Autorefraction: +3 -3.75 x 87. IOP 16 mmHg. Female patient: 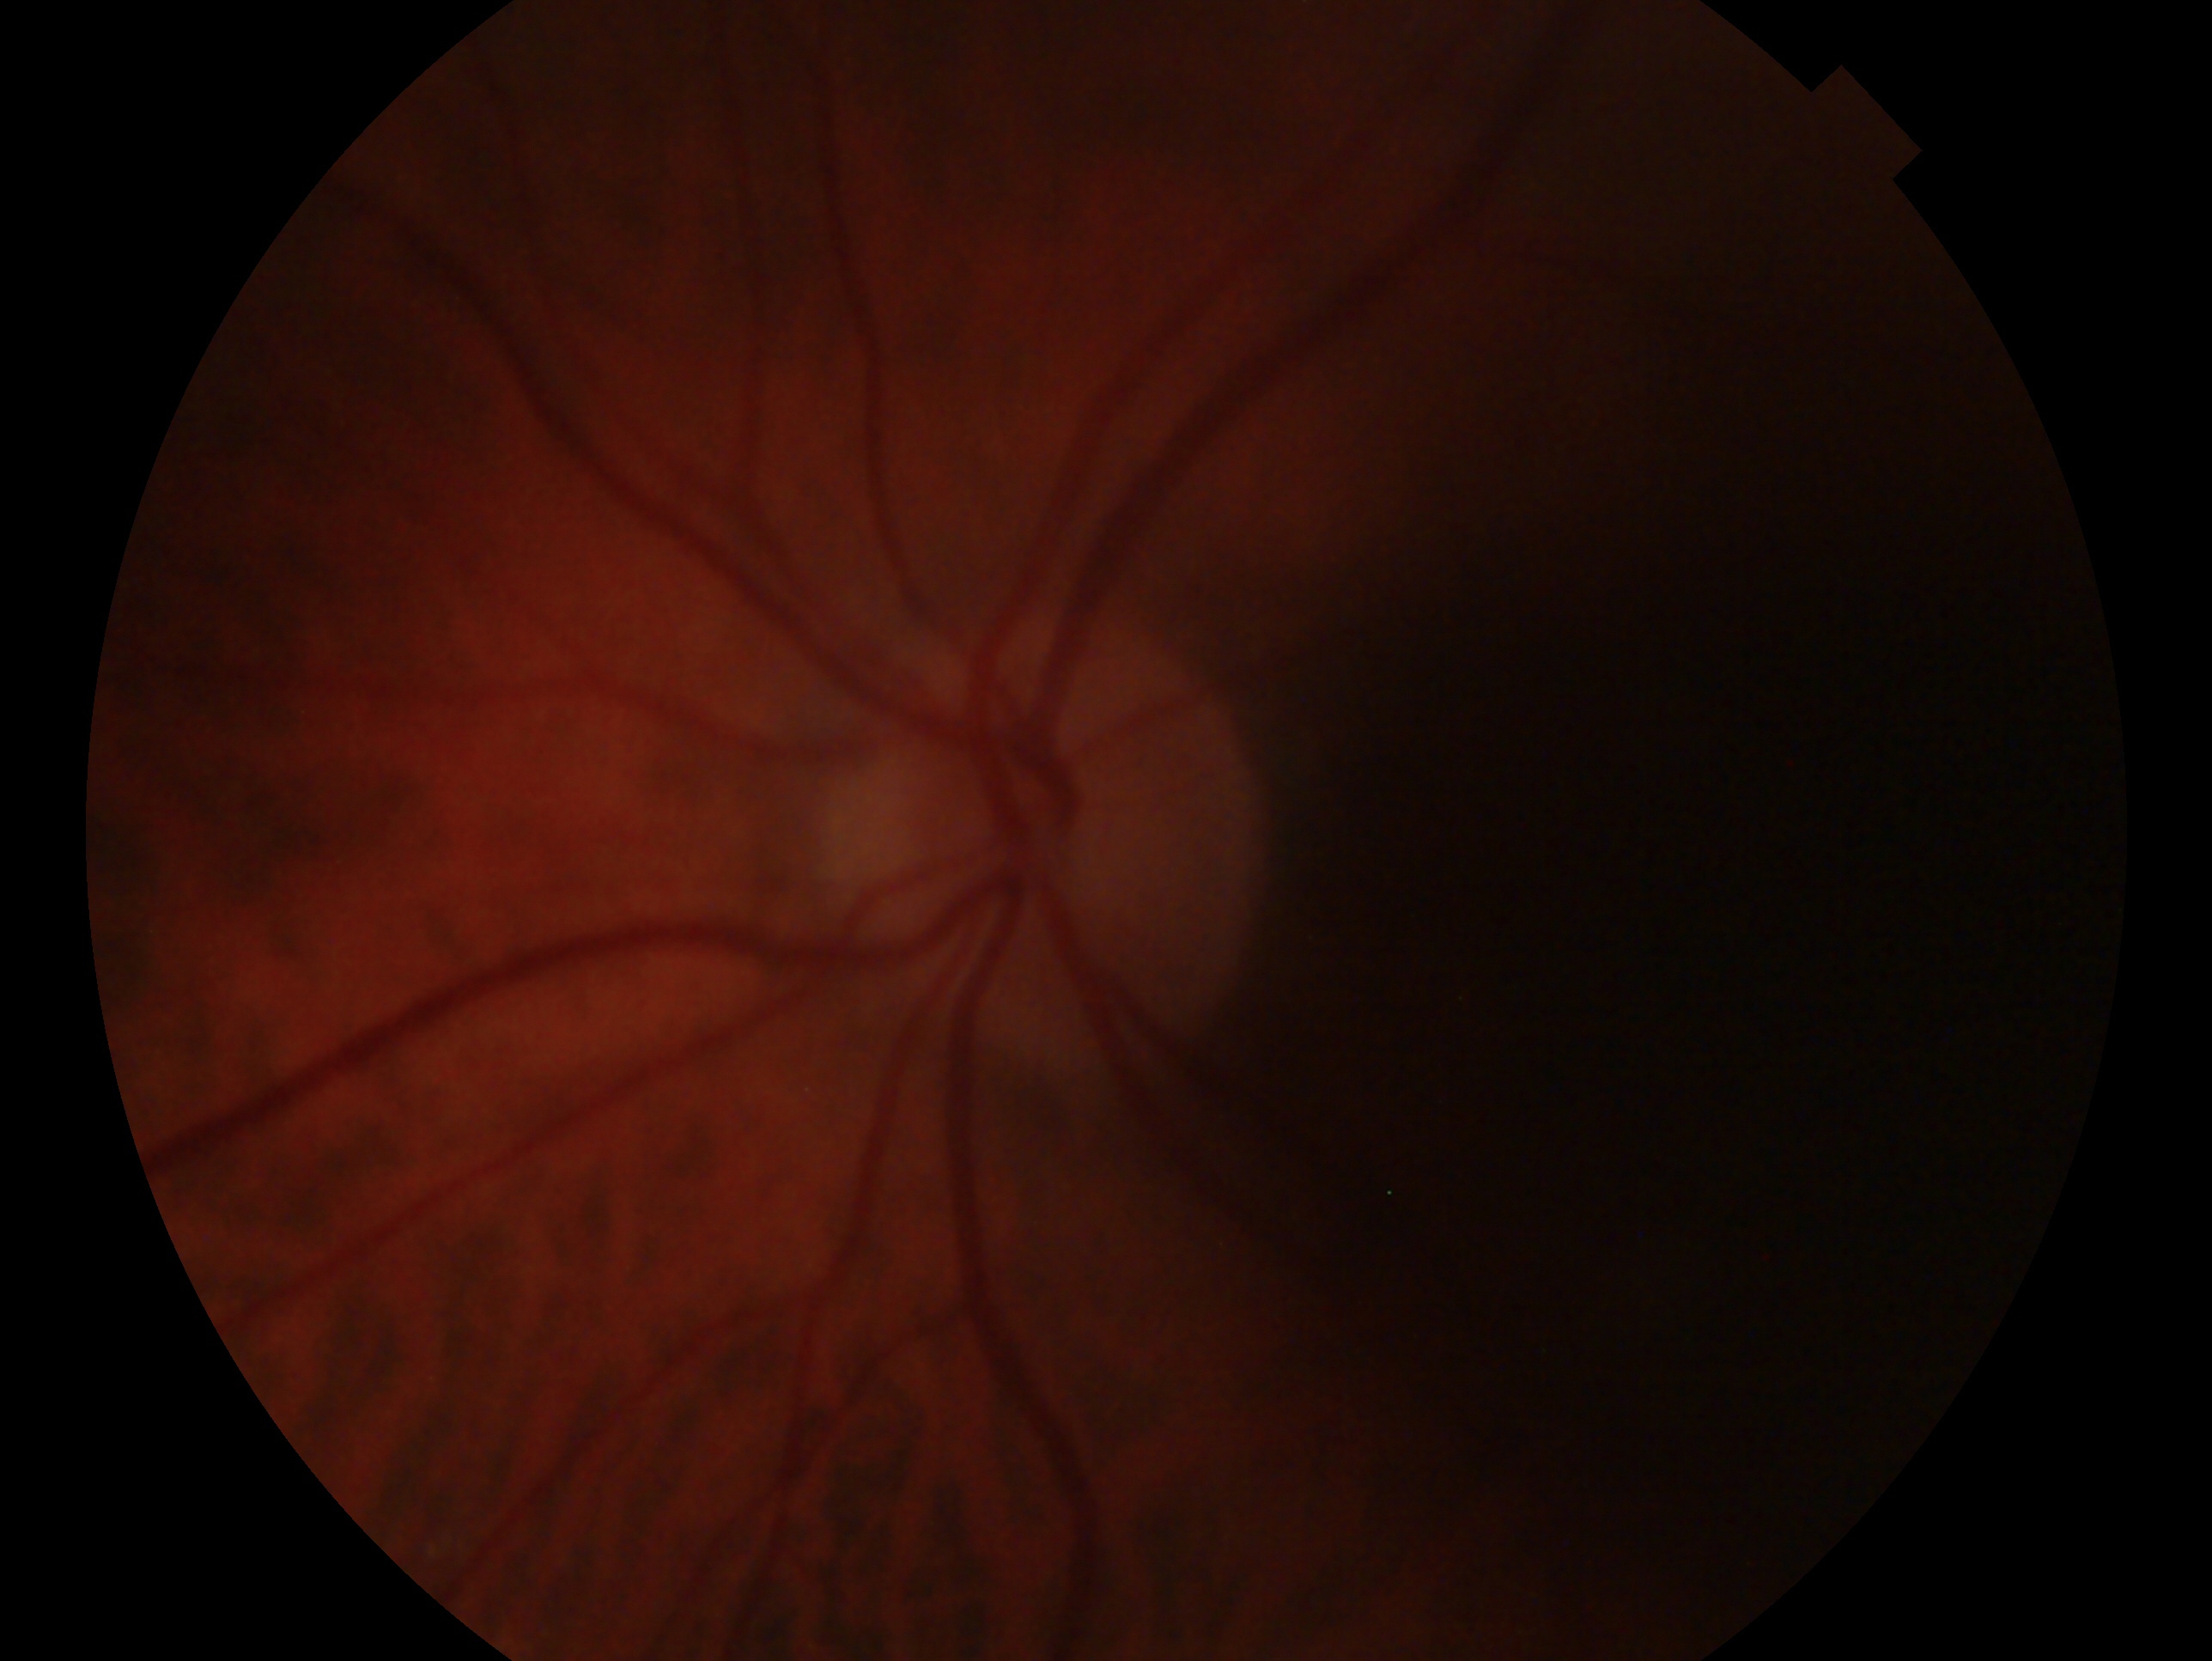

The image shows the oculus sinister. Glaucoma status: negative for glaucoma.